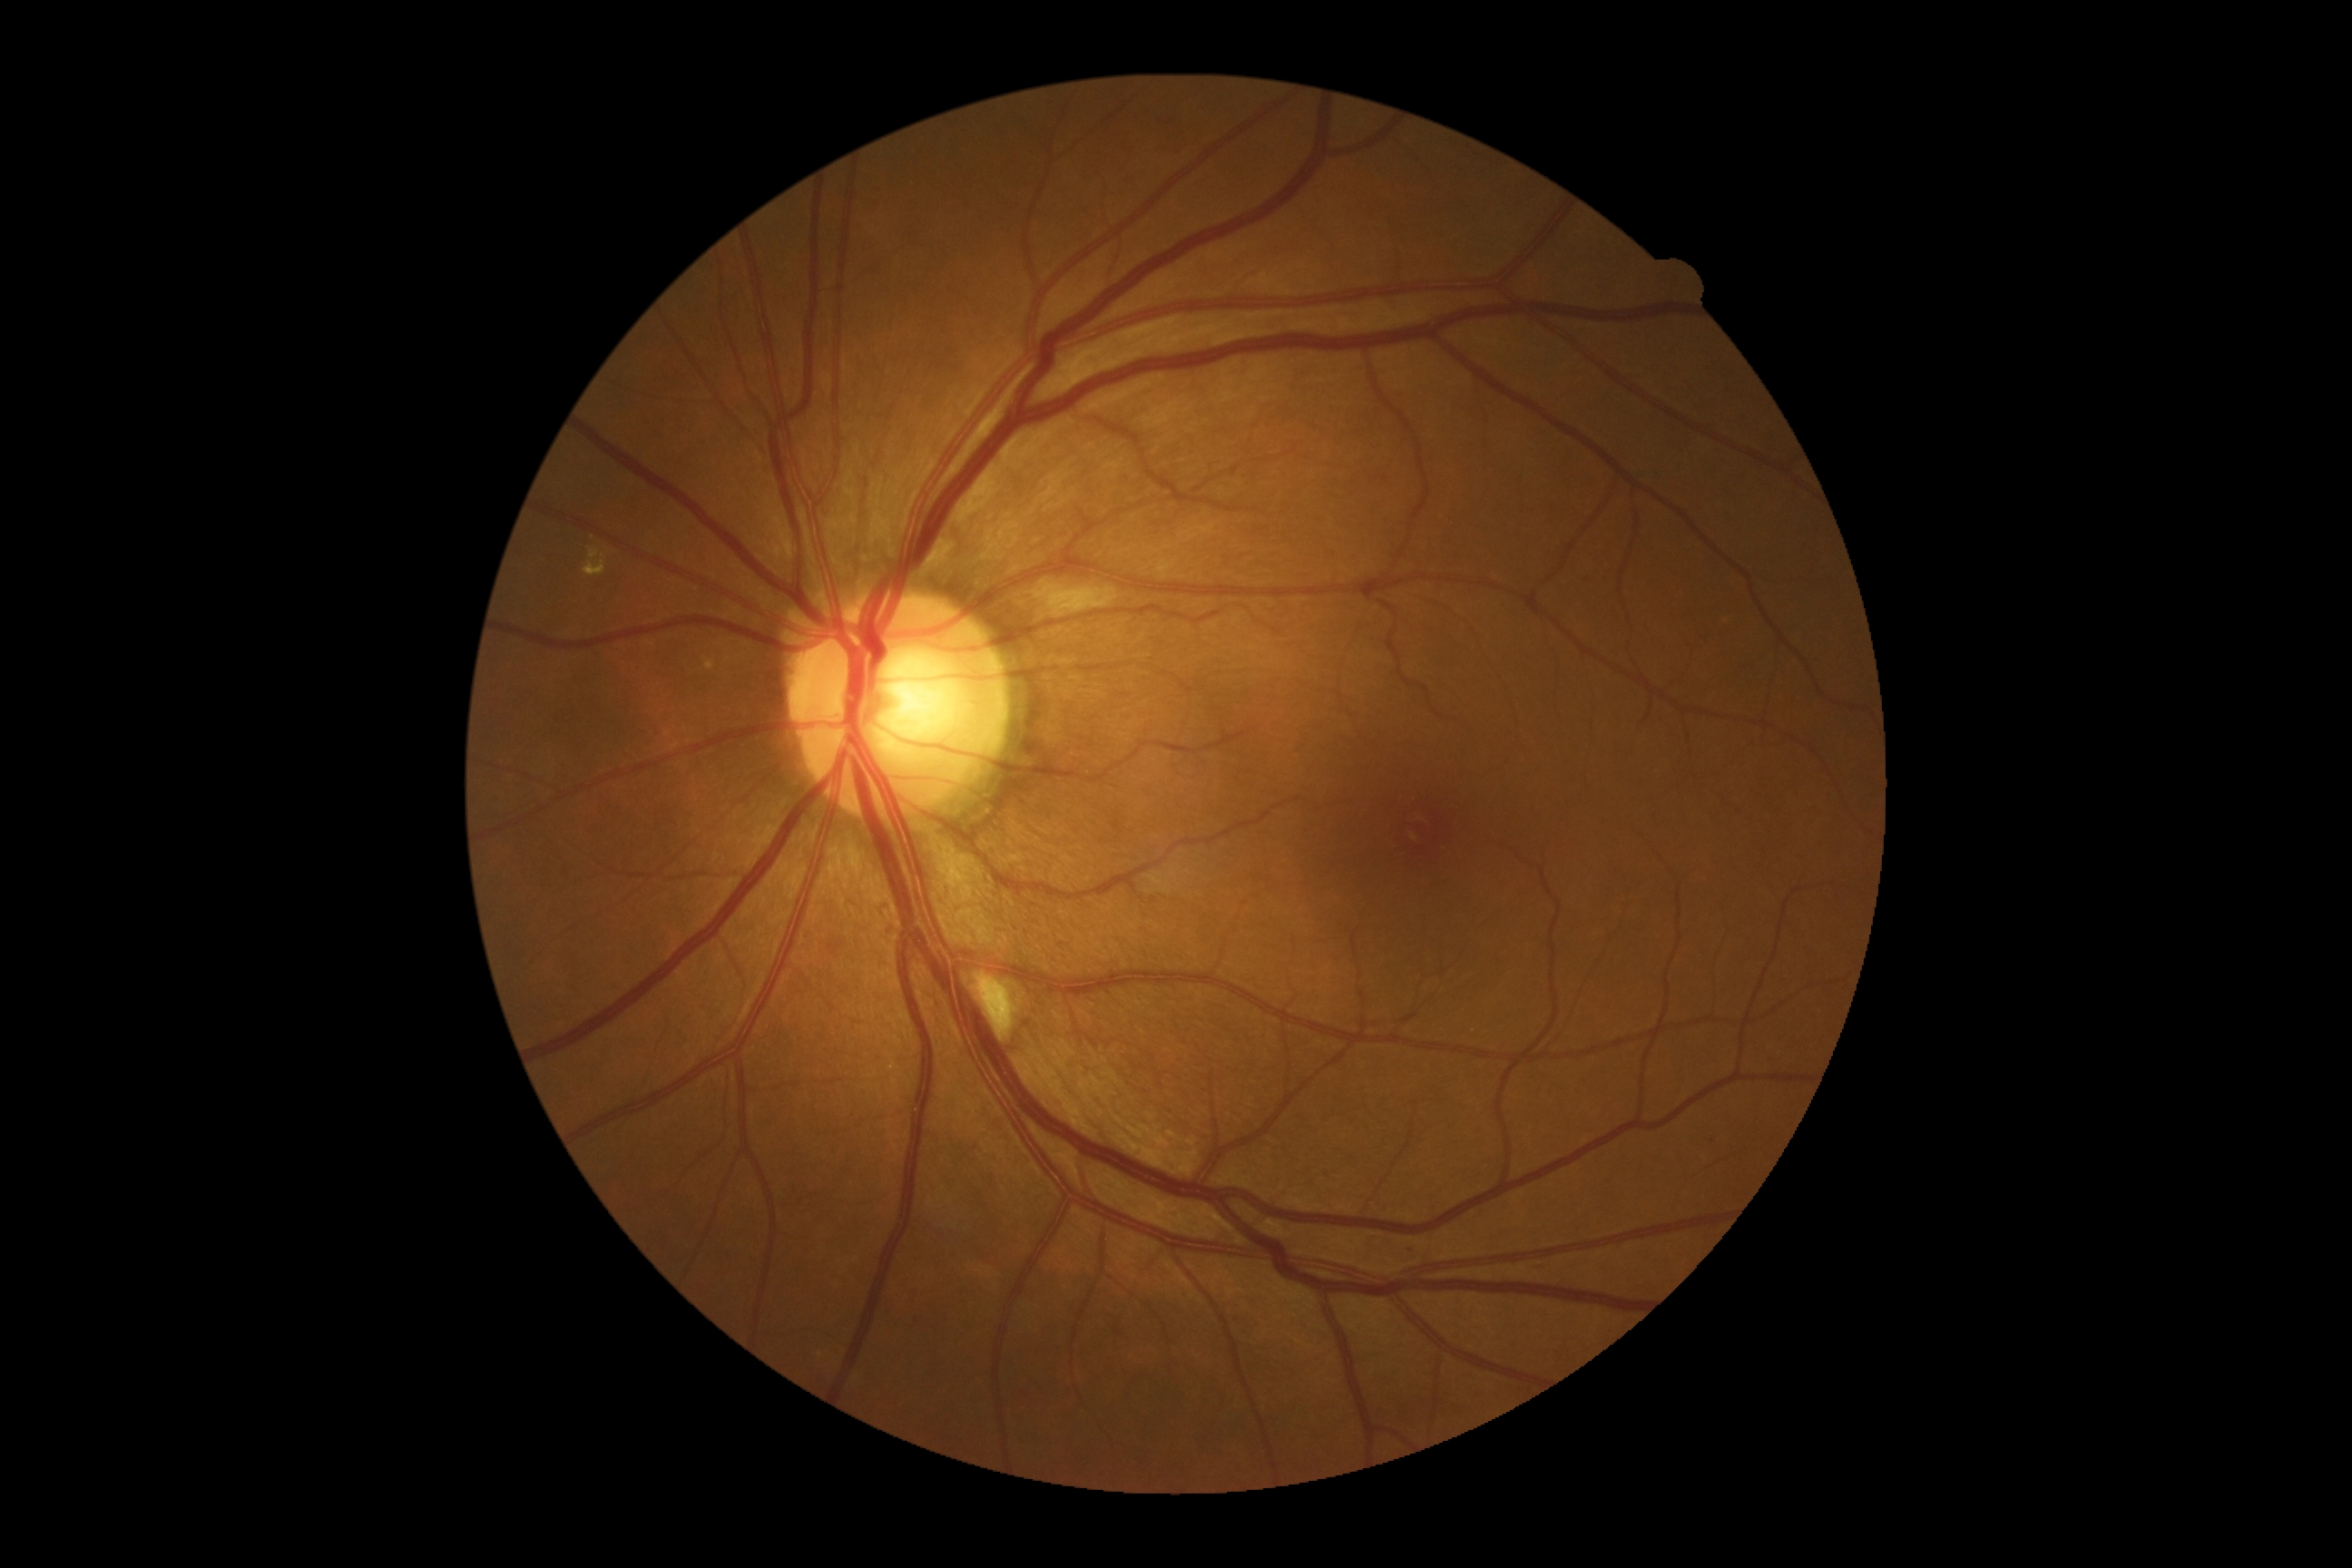 dr_grade: 2 (moderate NPDR)